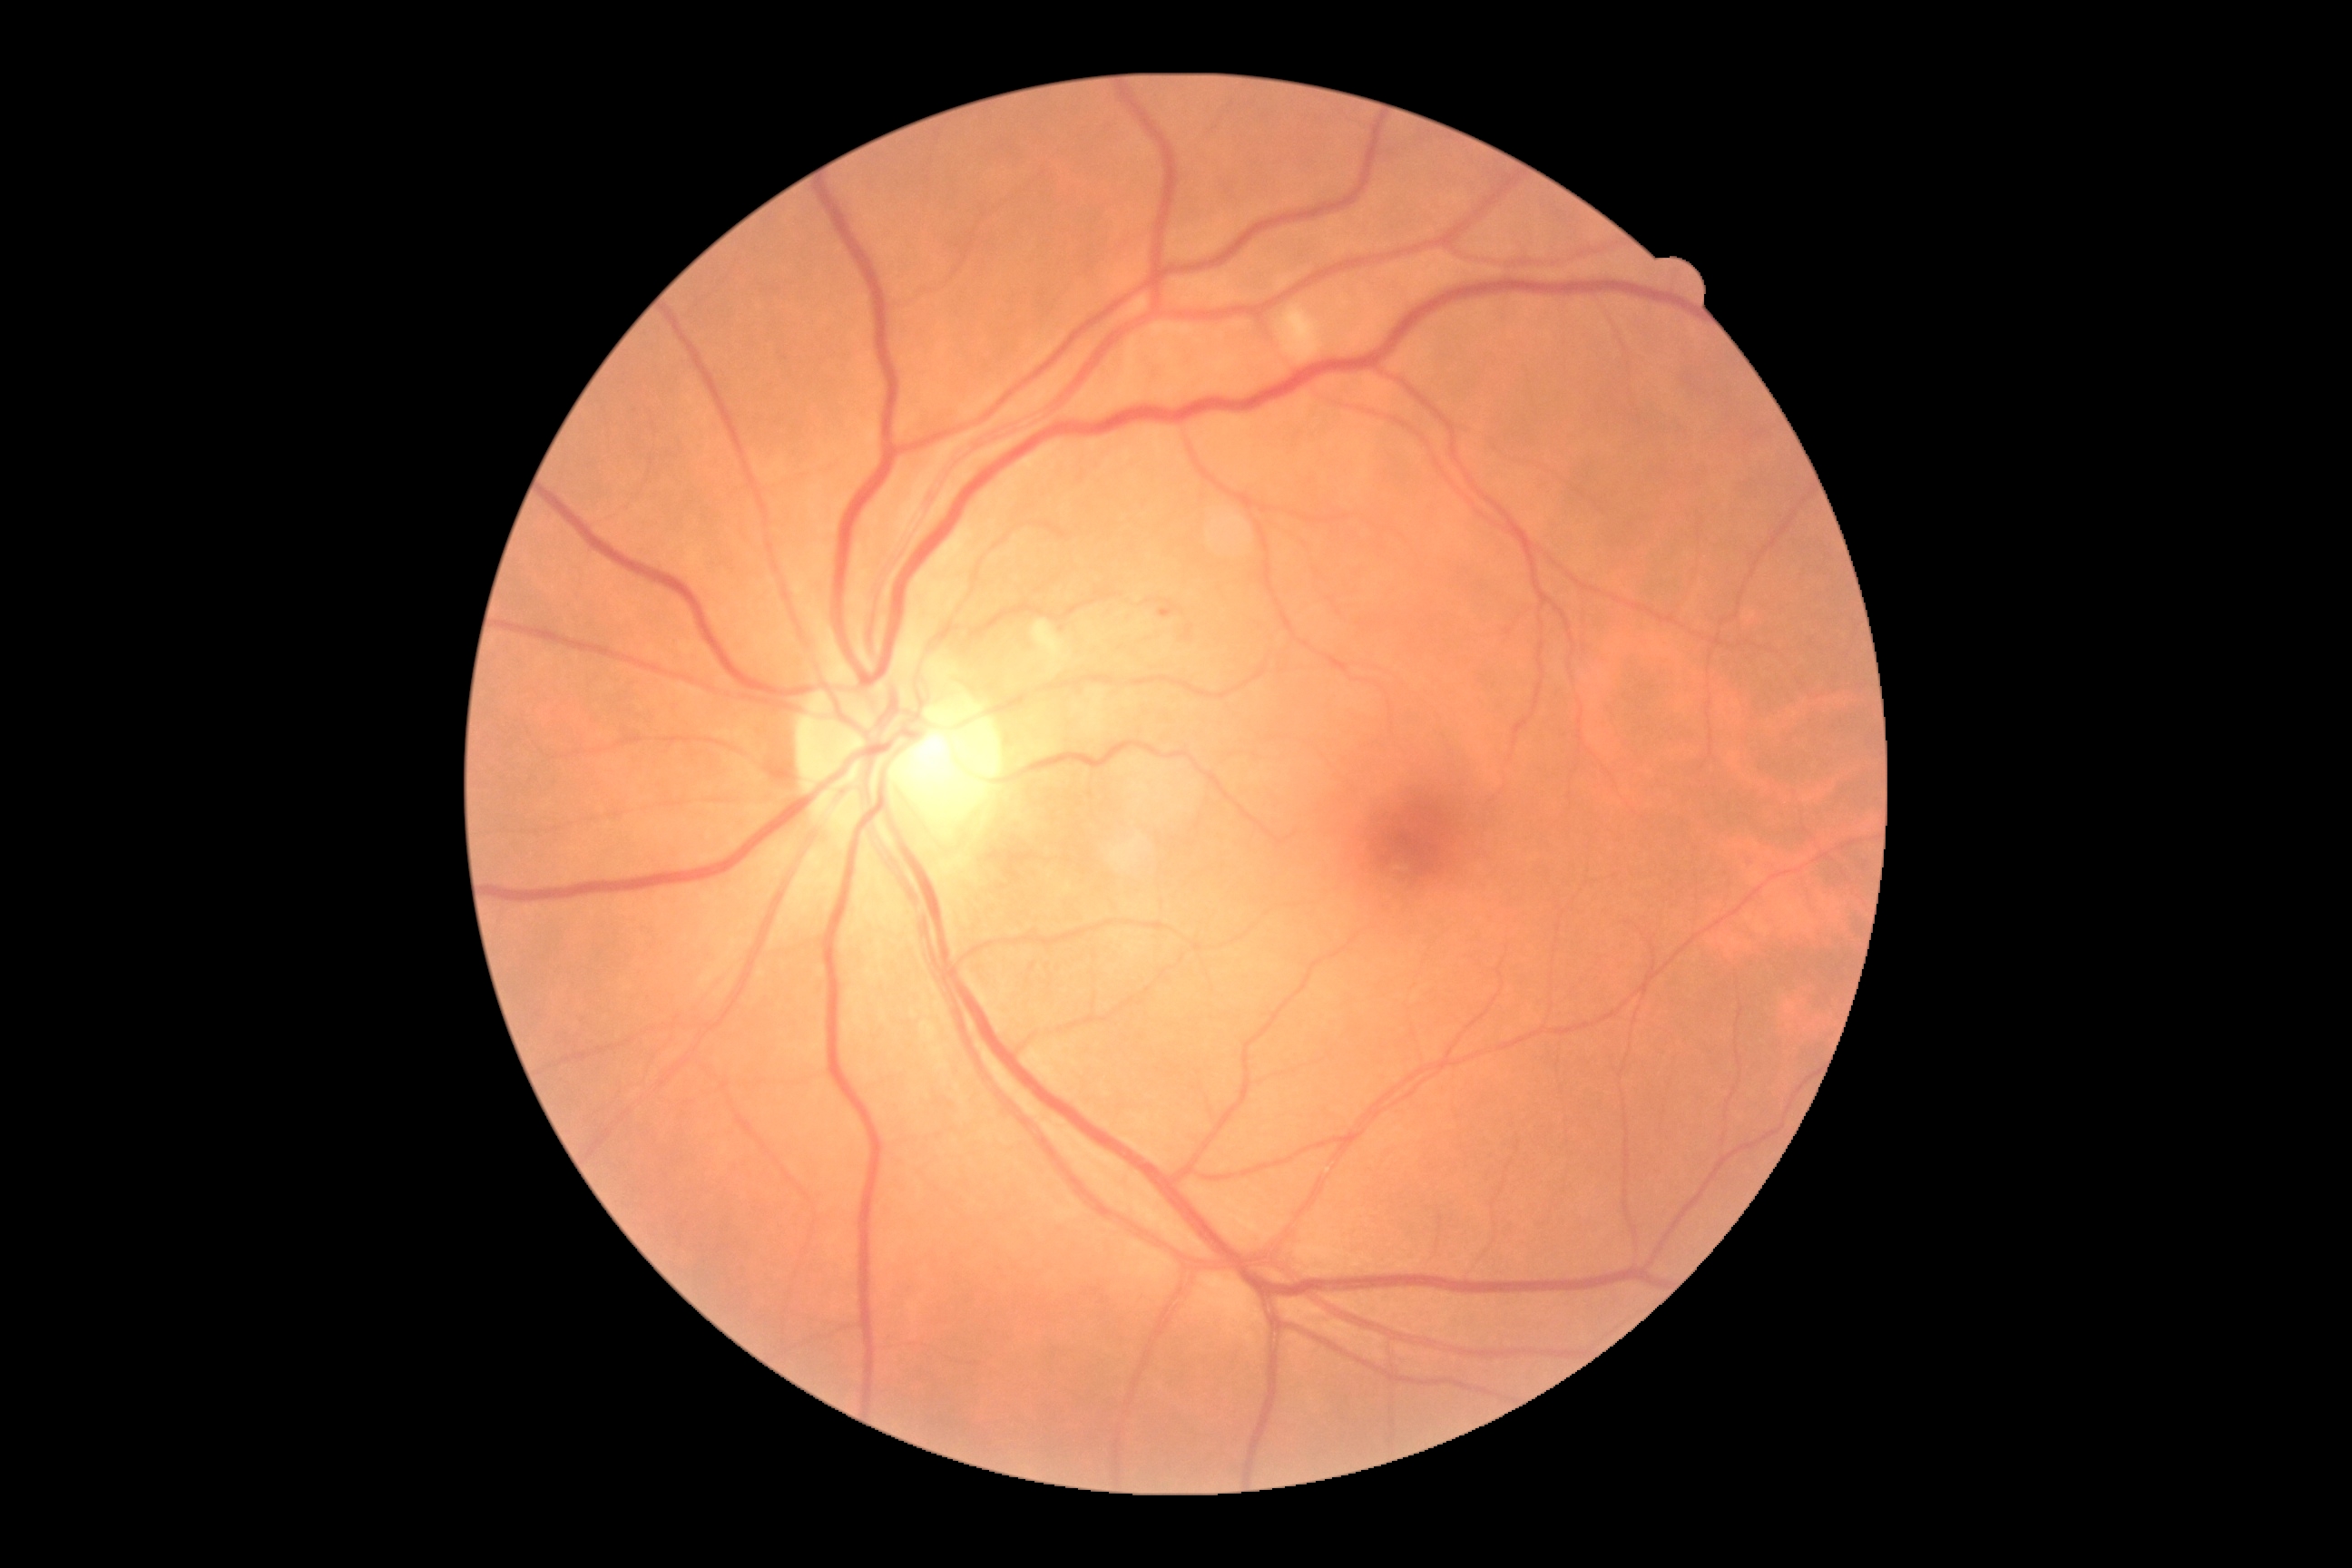
Diabetic retinopathy severity is moderate non-proliferative diabetic retinopathy (grade 2).